Image size 1932x1910: 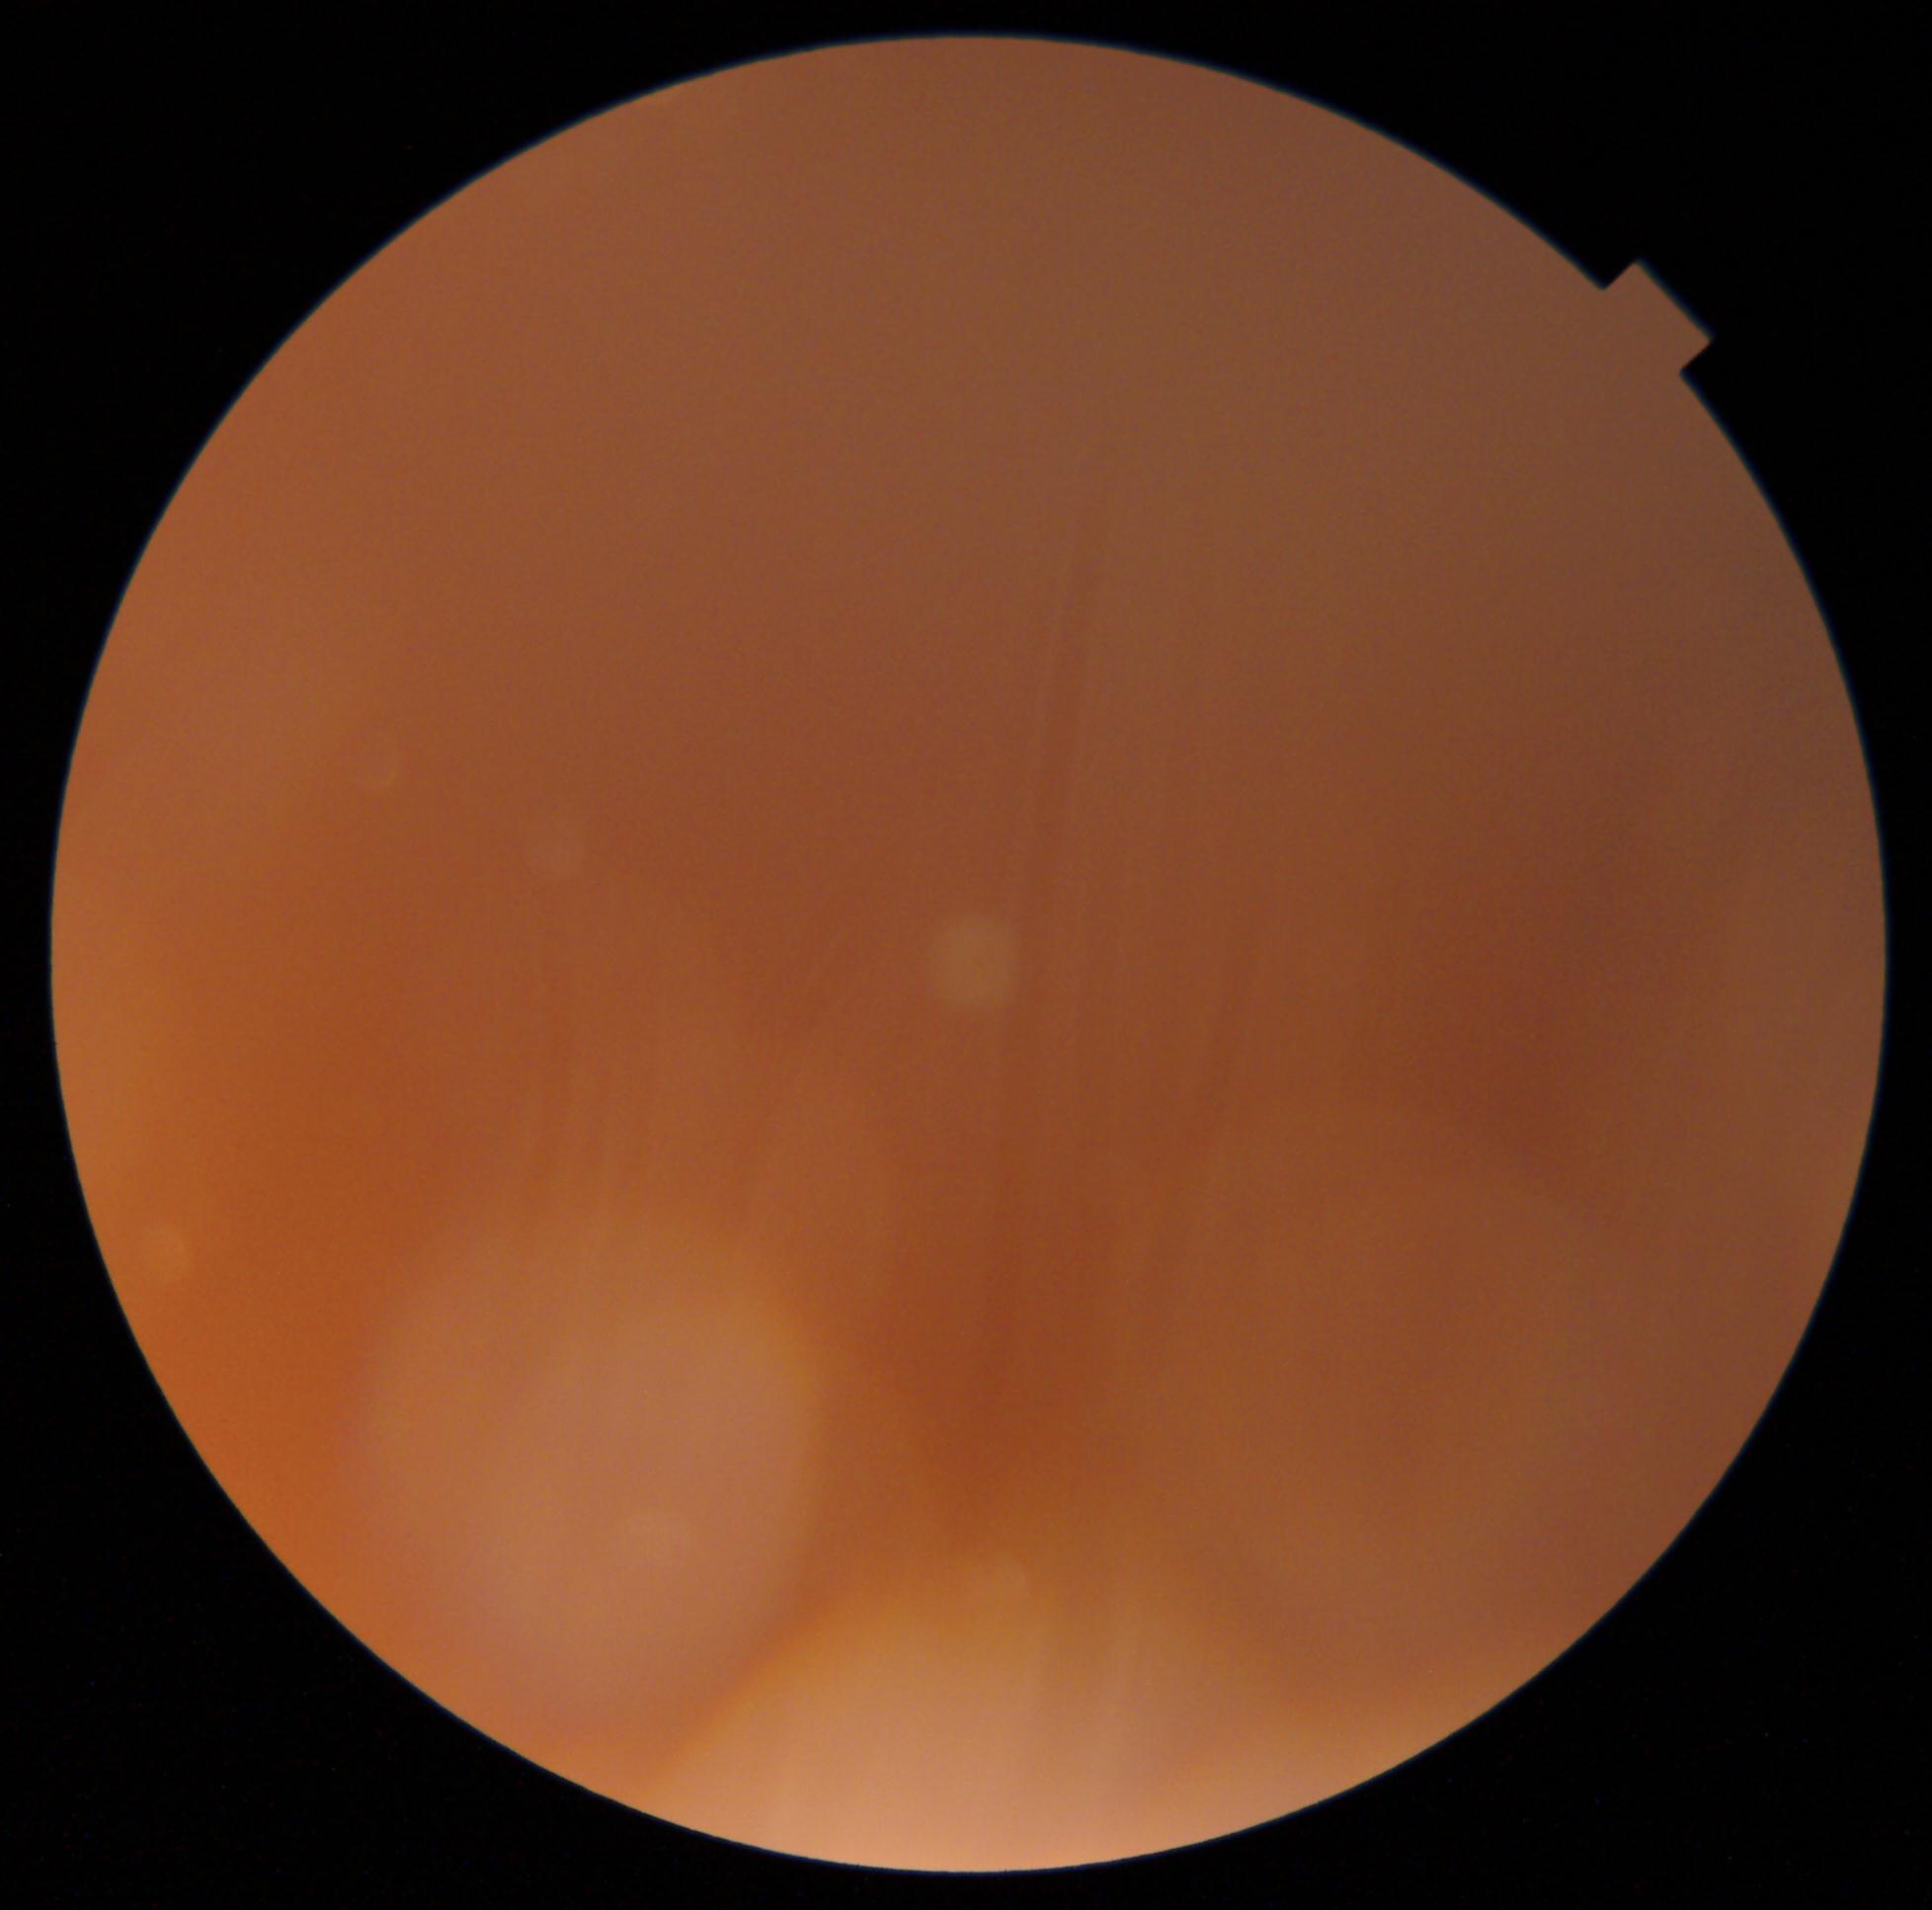

Diabetic retinopathy (DR) is ungradable due to poor image quality.
The image cannot be graded for diabetic retinopathy.